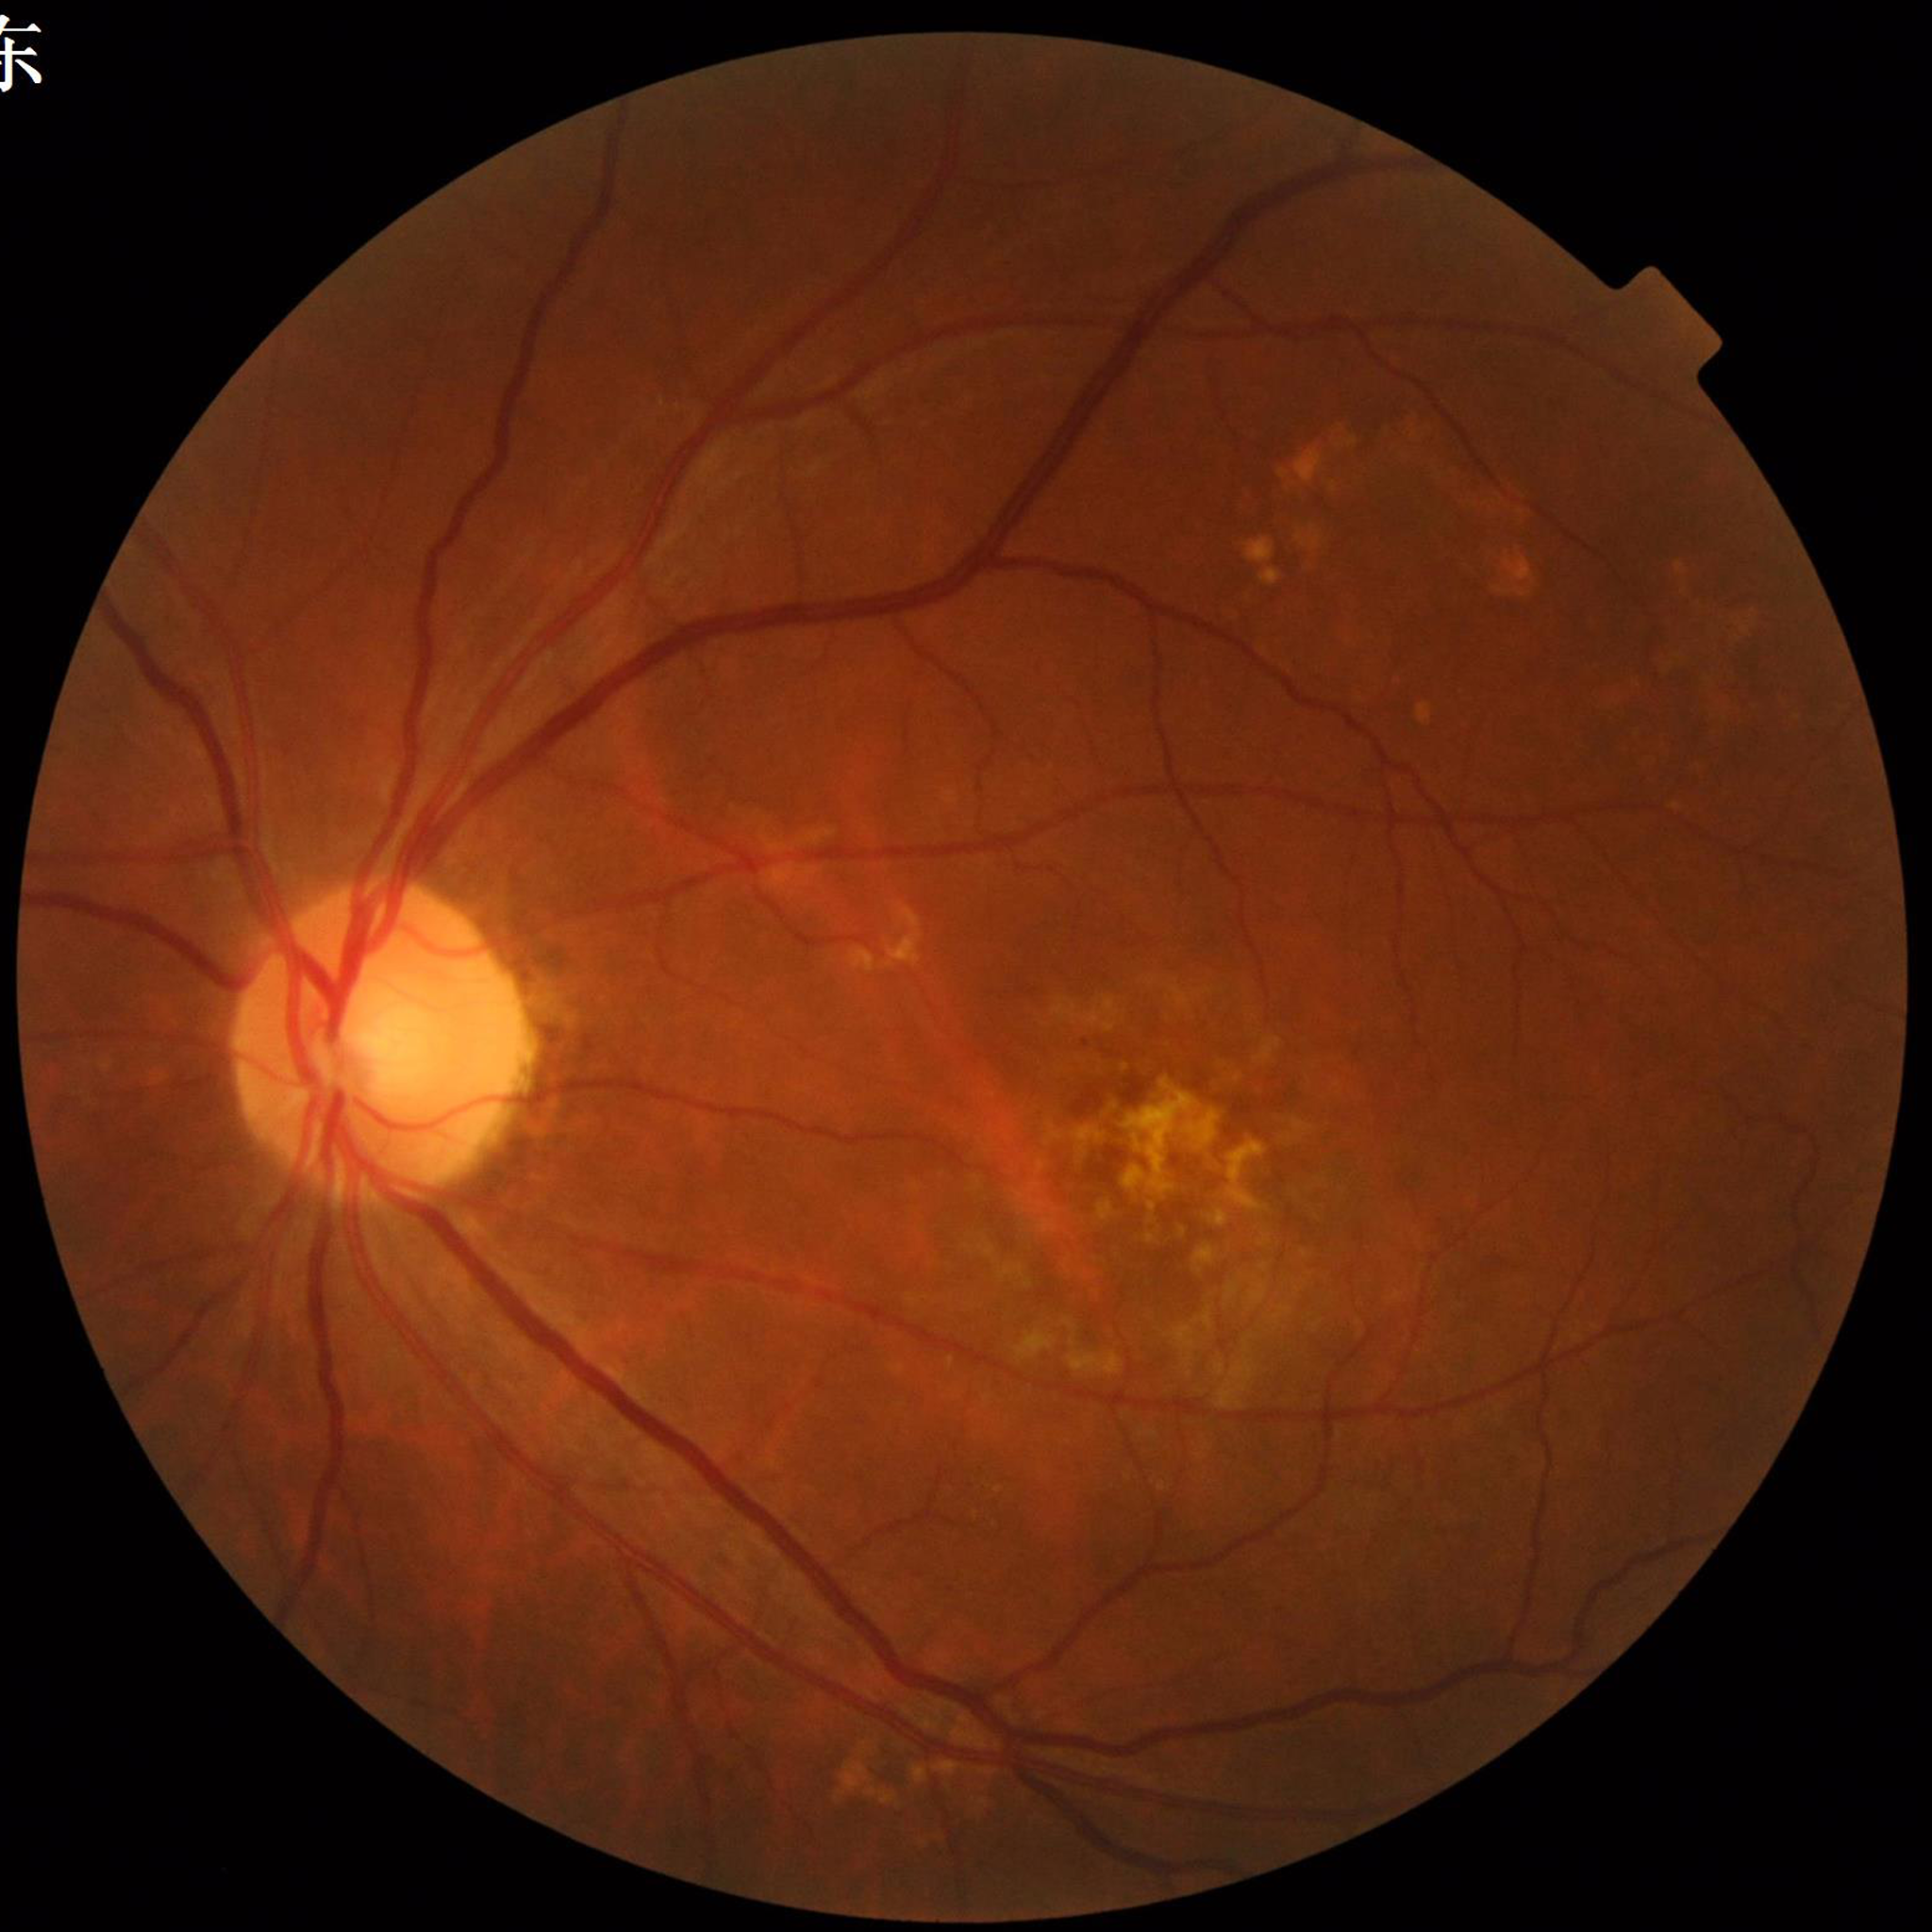 {
  "diagnosis": "AMD"
}